Centered on the optic disc · axial length 25.24 mm · 56-year-old patient · woman · color fundus photograph · intraocular pressure (Perkins applanation tonometry): 14 mmHg · pachymetry 537 µm · image size 2212x1661 · autorefraction: -3.75 -0.75 x 70: 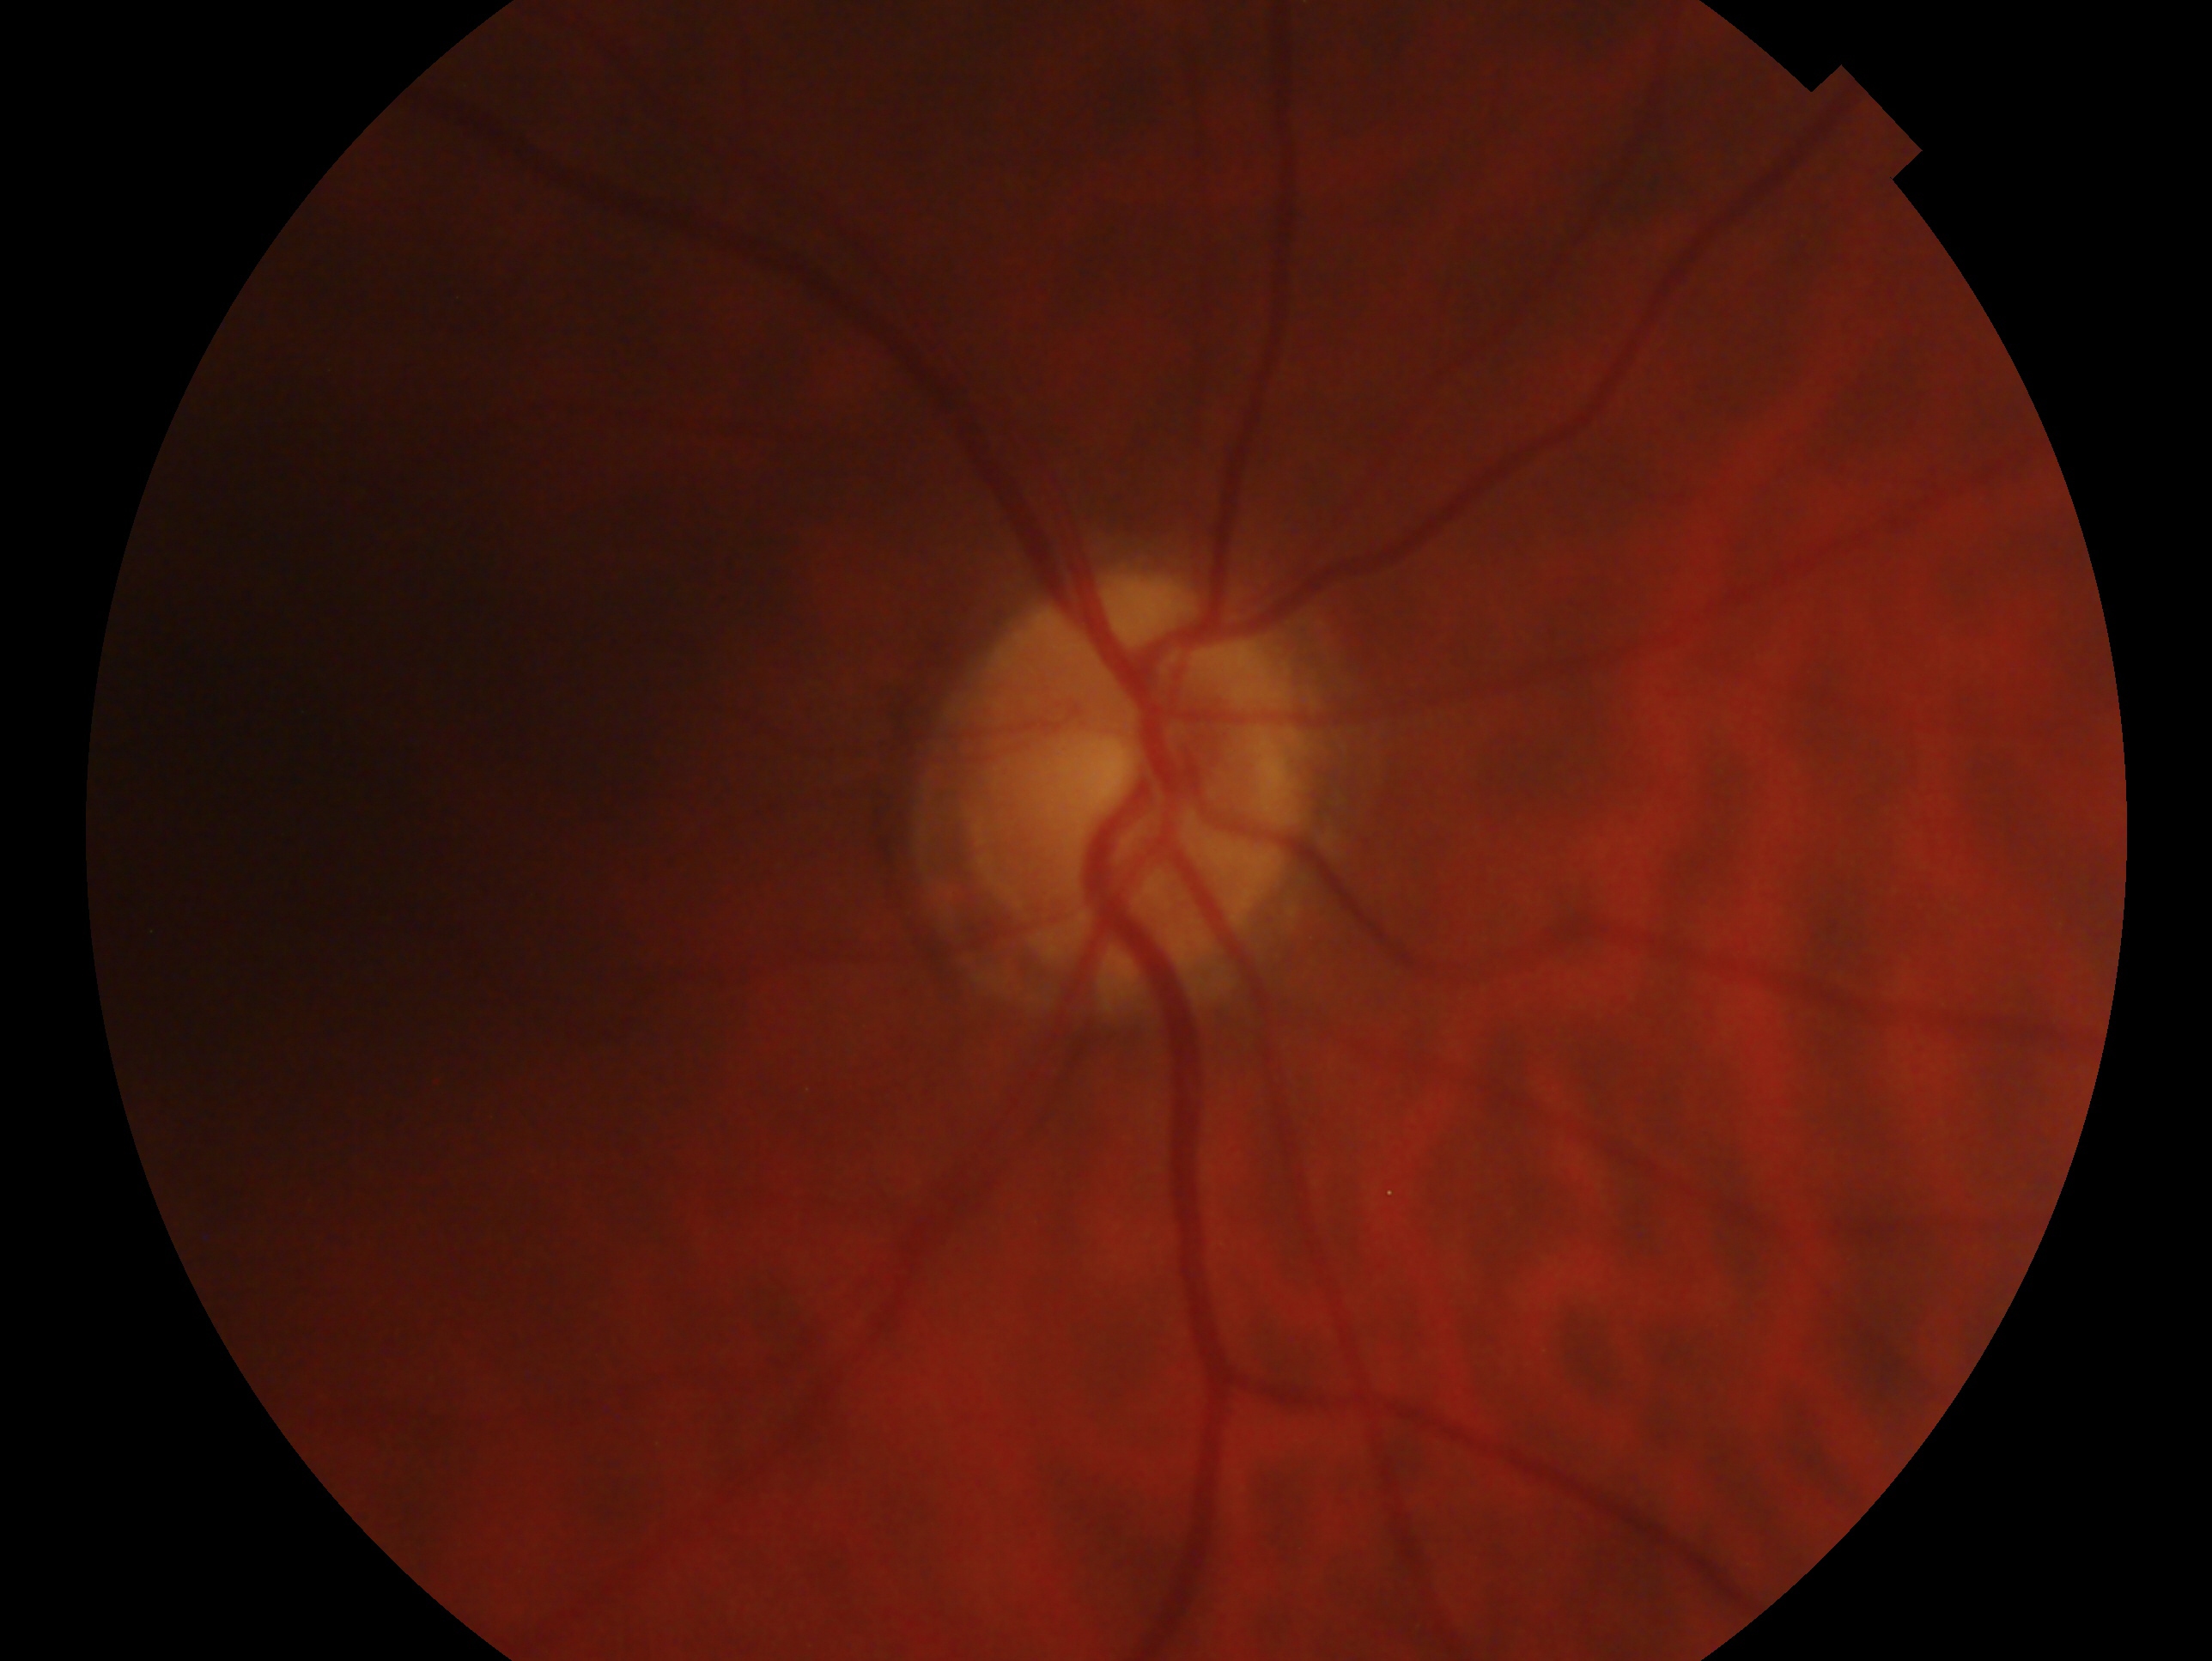
laterality = oculus dexter; glaucoma status = glaucomatous optic neuropathy.